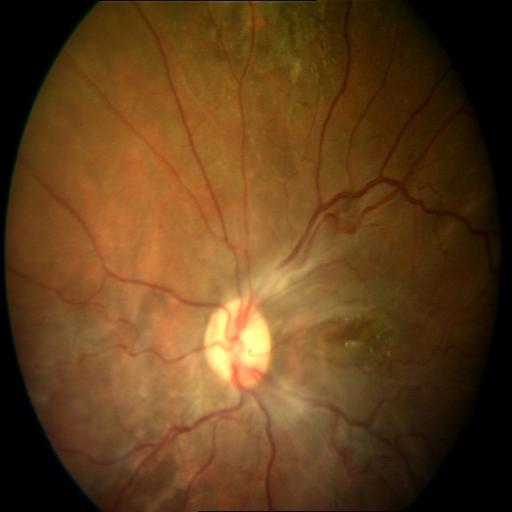 Fundus appearance consistent with chorioretinitis and epiretinal membrane.